Fundus photograph cropped around the optic nerve head — 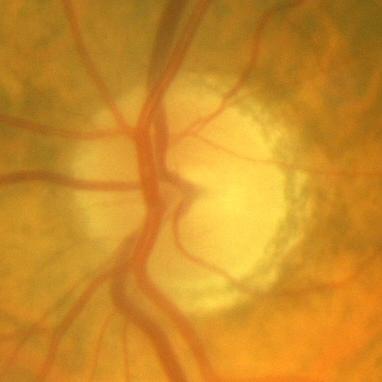
Glaucoma status = no signs of glaucoma.